1240 x 1240 pixels · wide-field fundus photograph from neonatal ROP screening
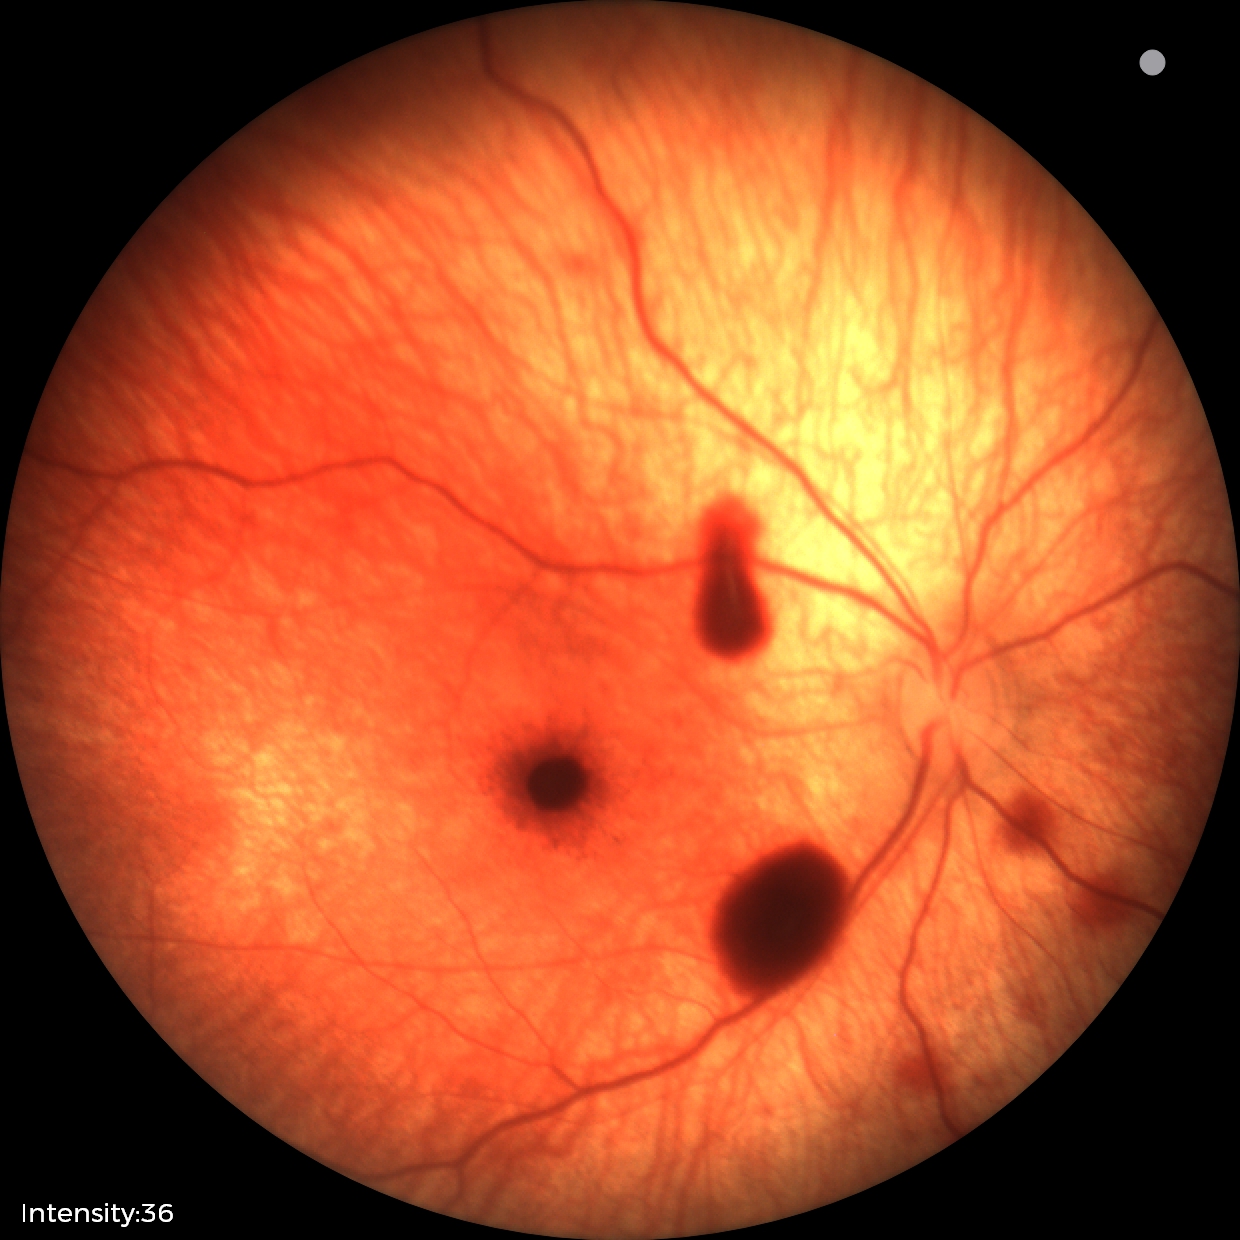

Q: What is the screening diagnosis?
A: retinal hemorrhages